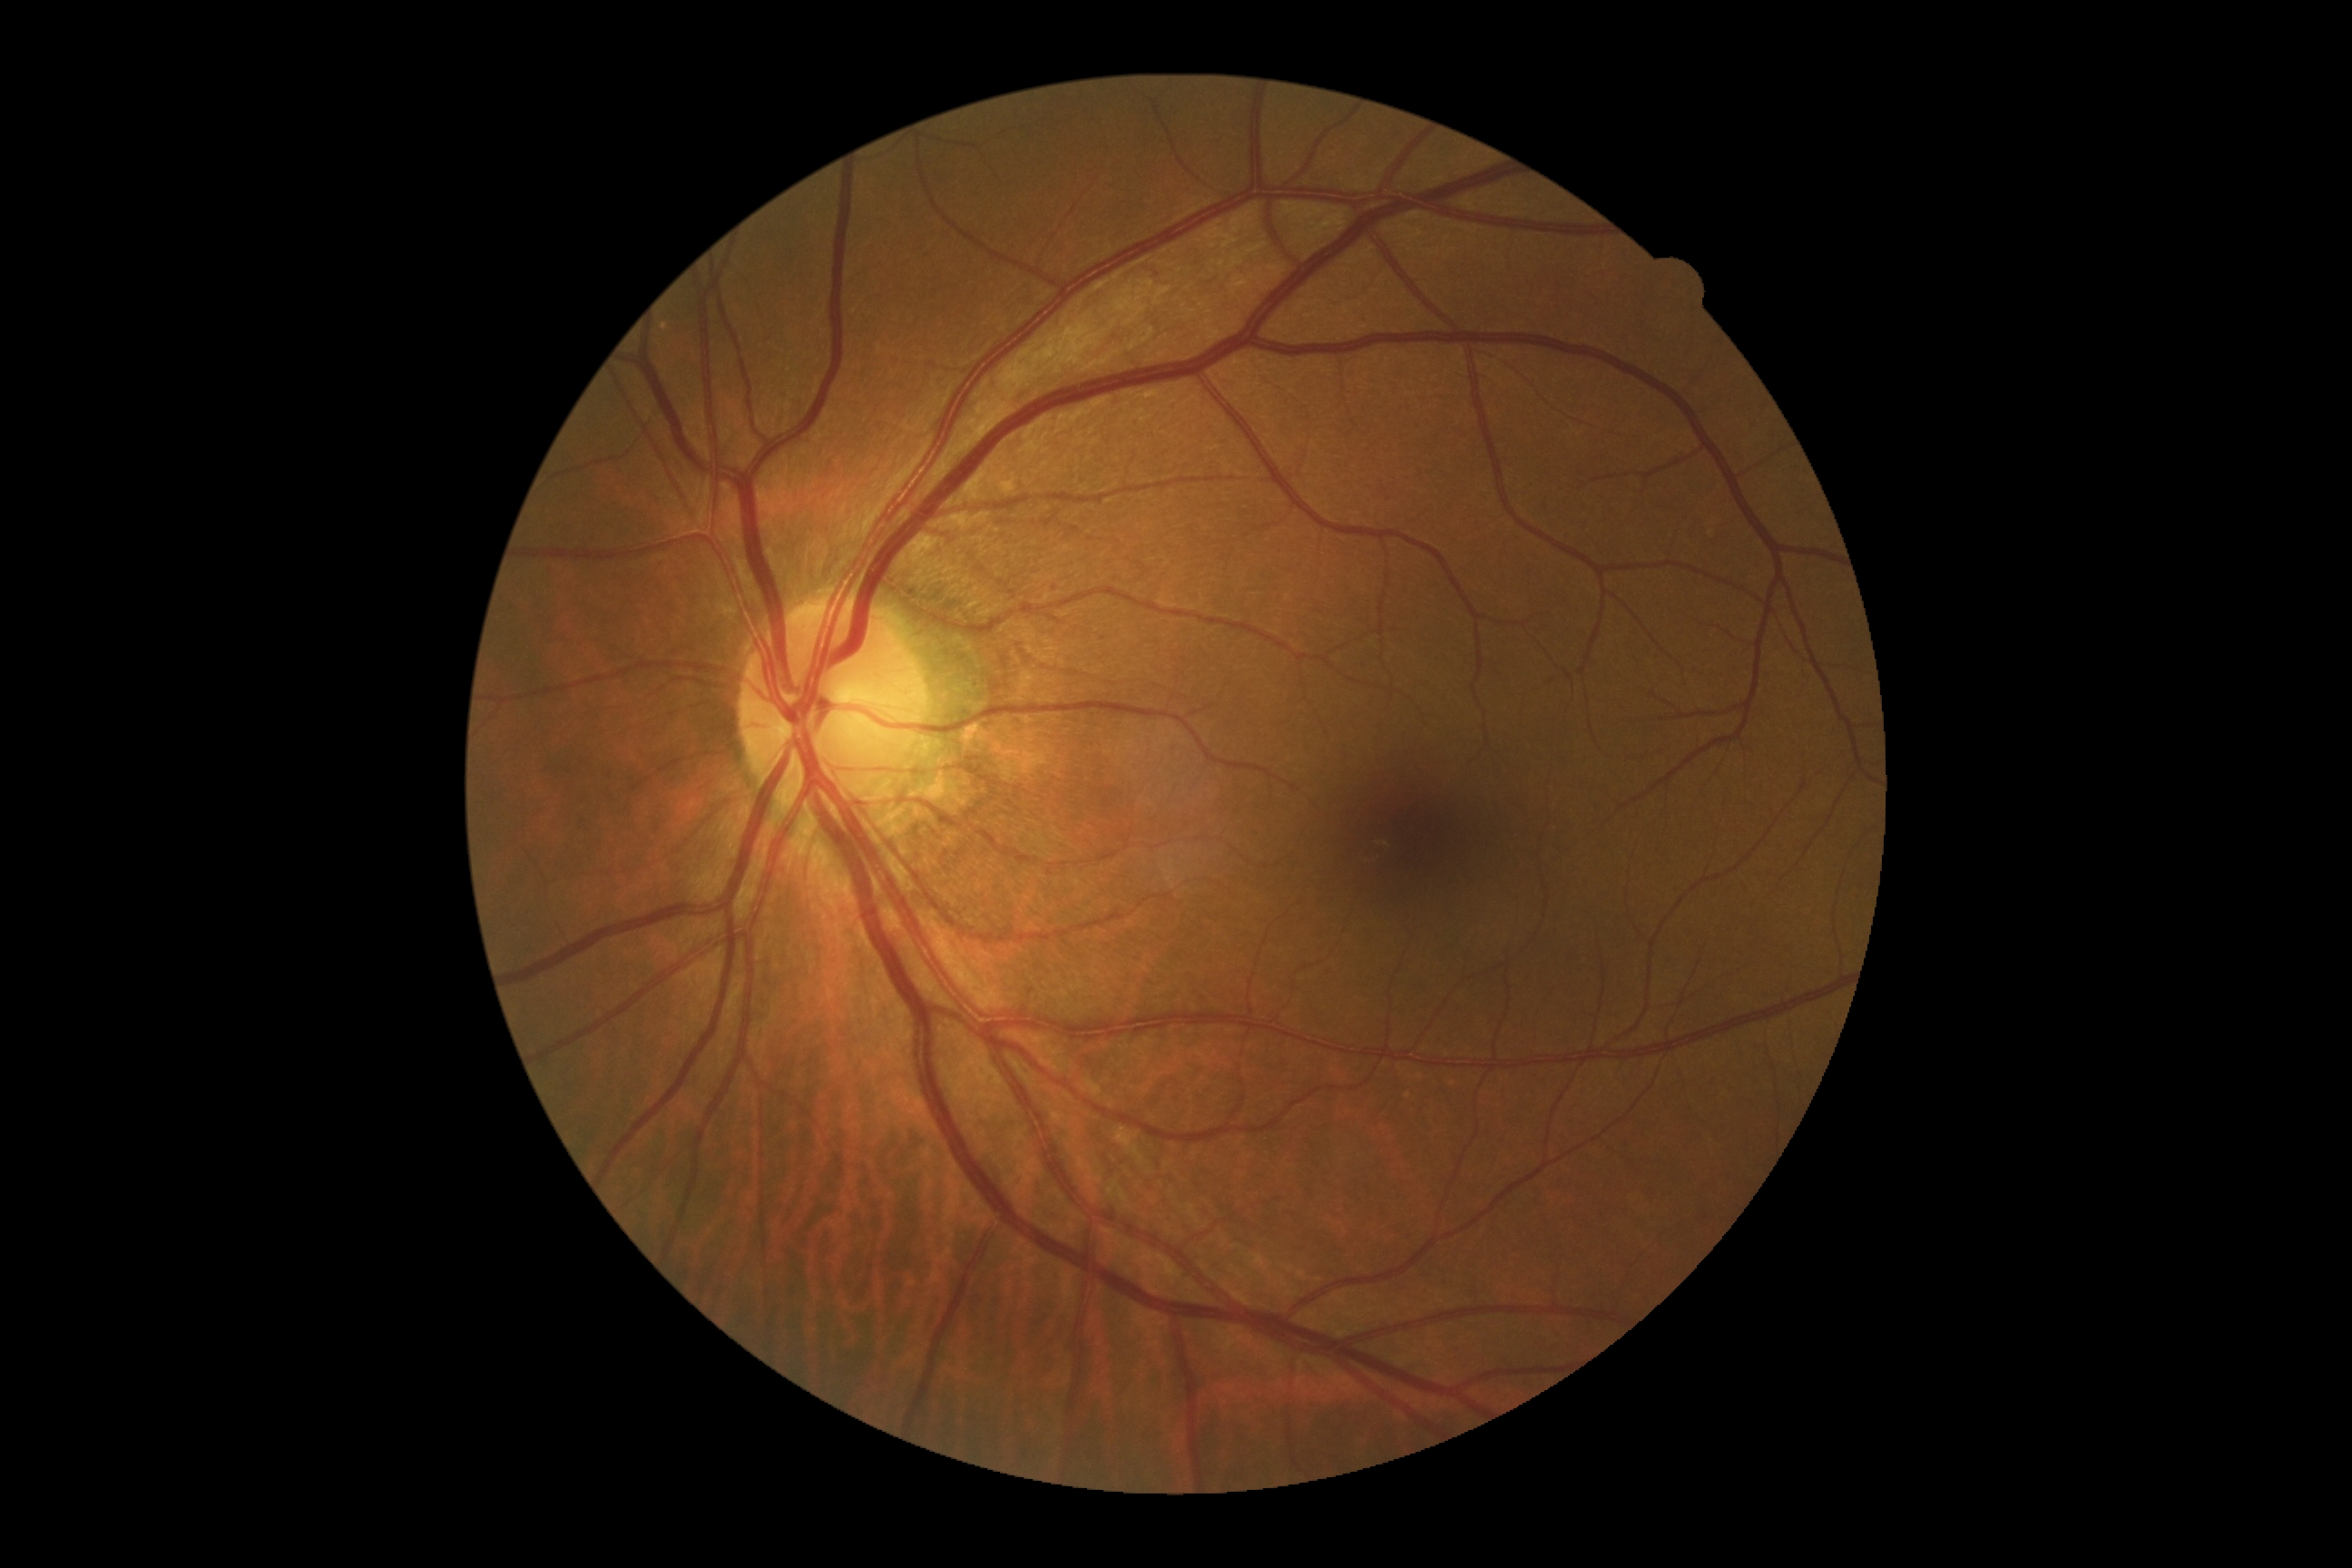 diabetic retinopathy grade: 0